50° field of view · camera: Topcon TRC-NW8 · 1932x1932px:
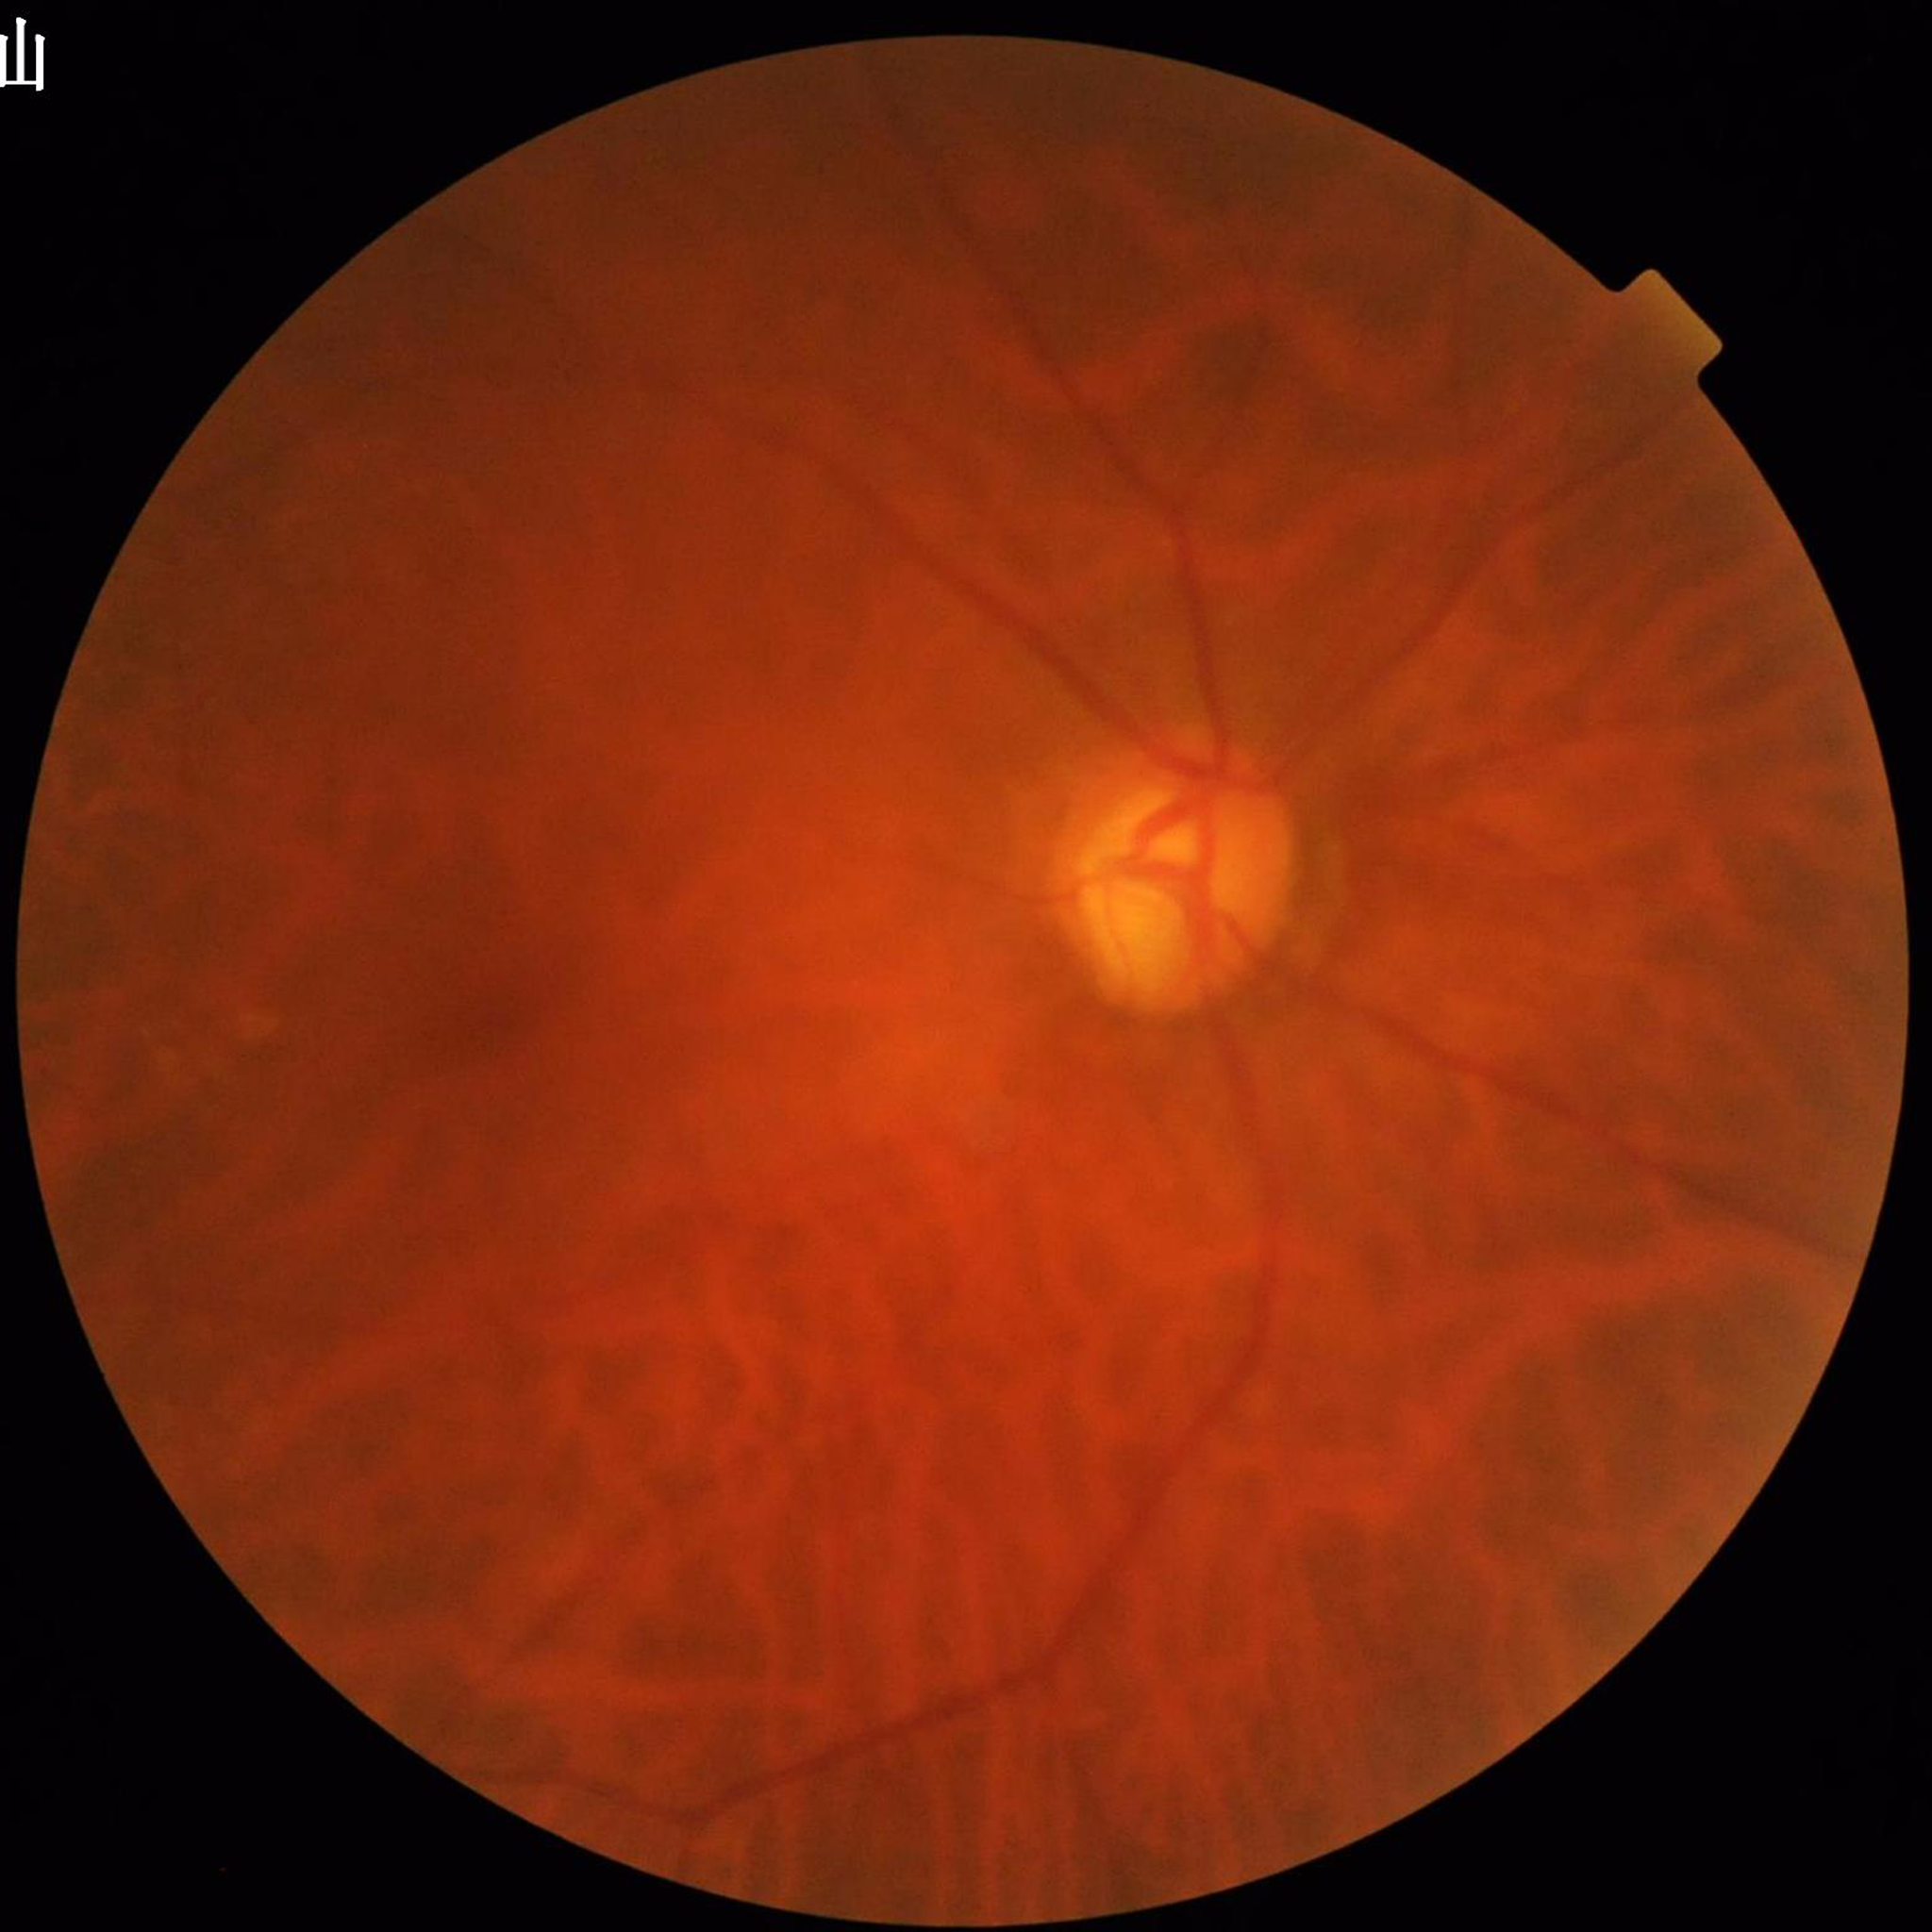
Quality: reduced — blur. Eye affected by glaucoma.